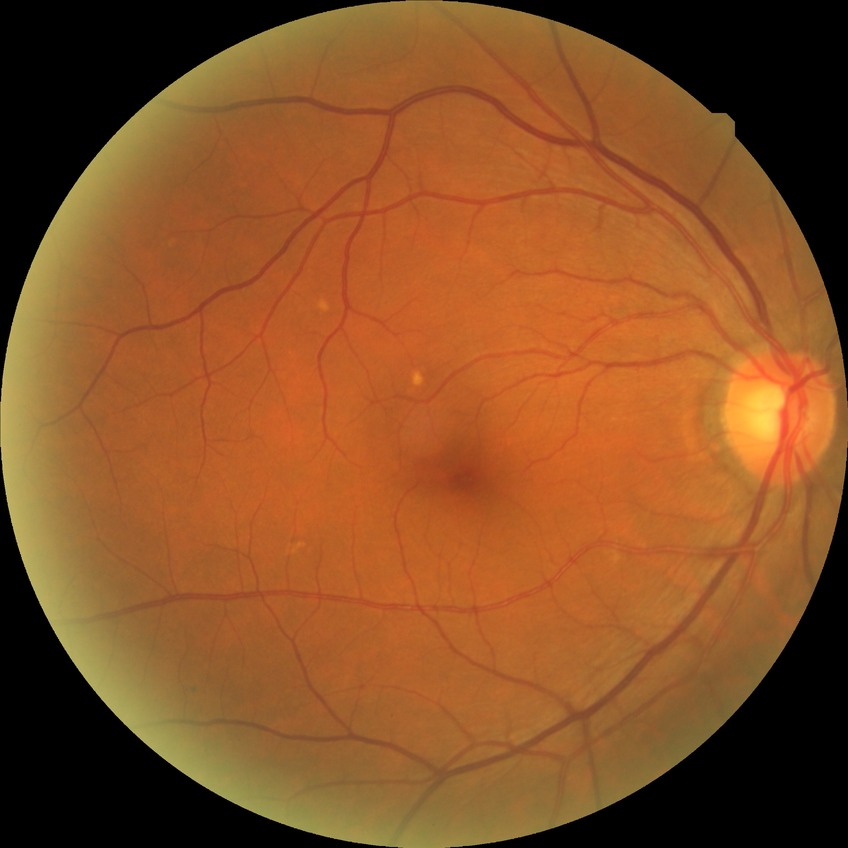 Diabetic retinopathy (DR) is NDR (no diabetic retinopathy).